Davis DR grading.
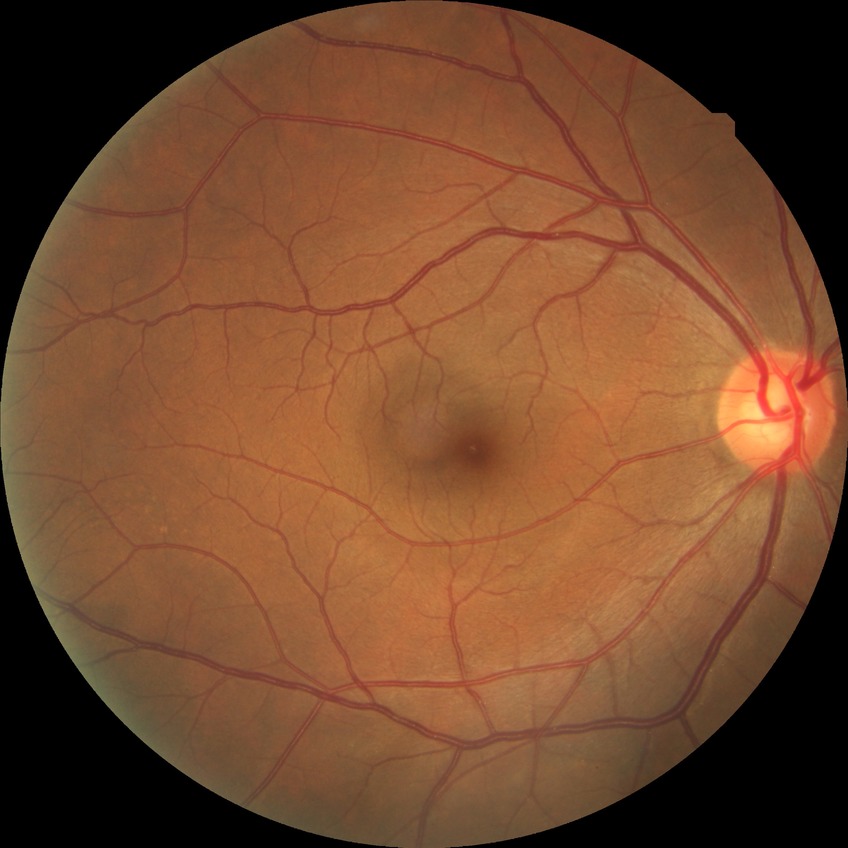 DR stage is NDR.